2212x1659, 45° FOV — 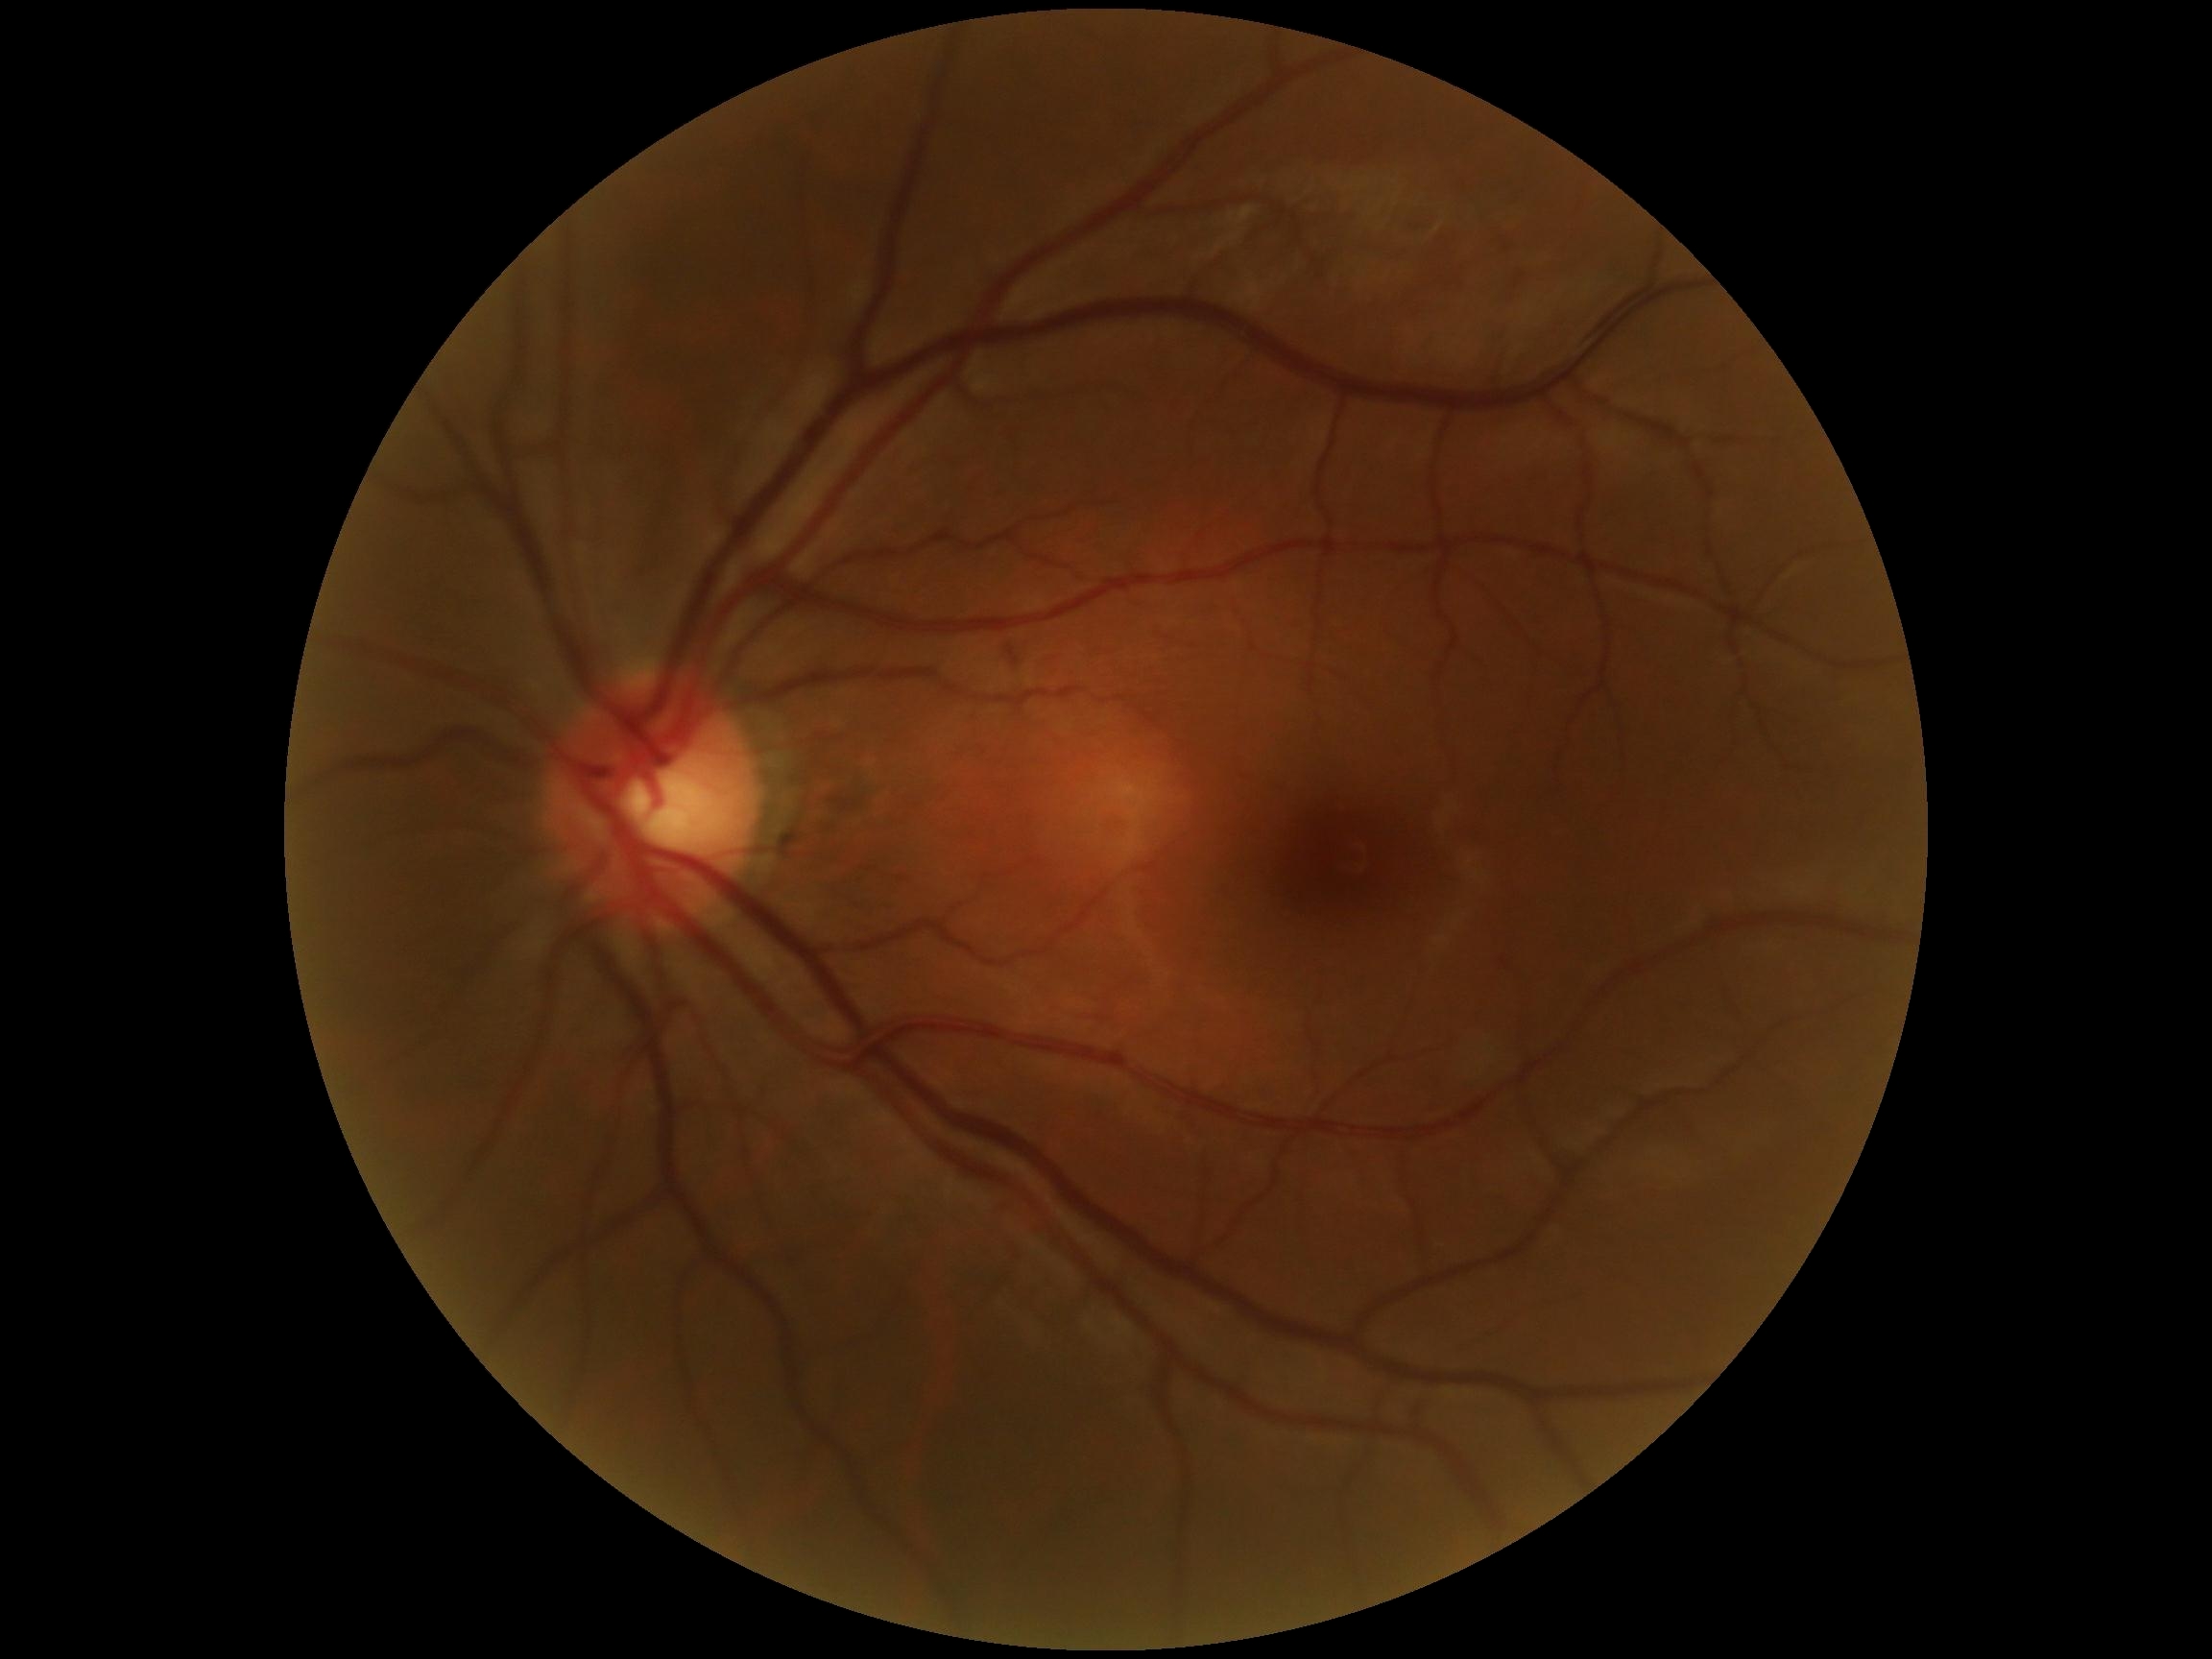 DR: grade 0. No signs of diabetic retinopathy.